45° field of view — 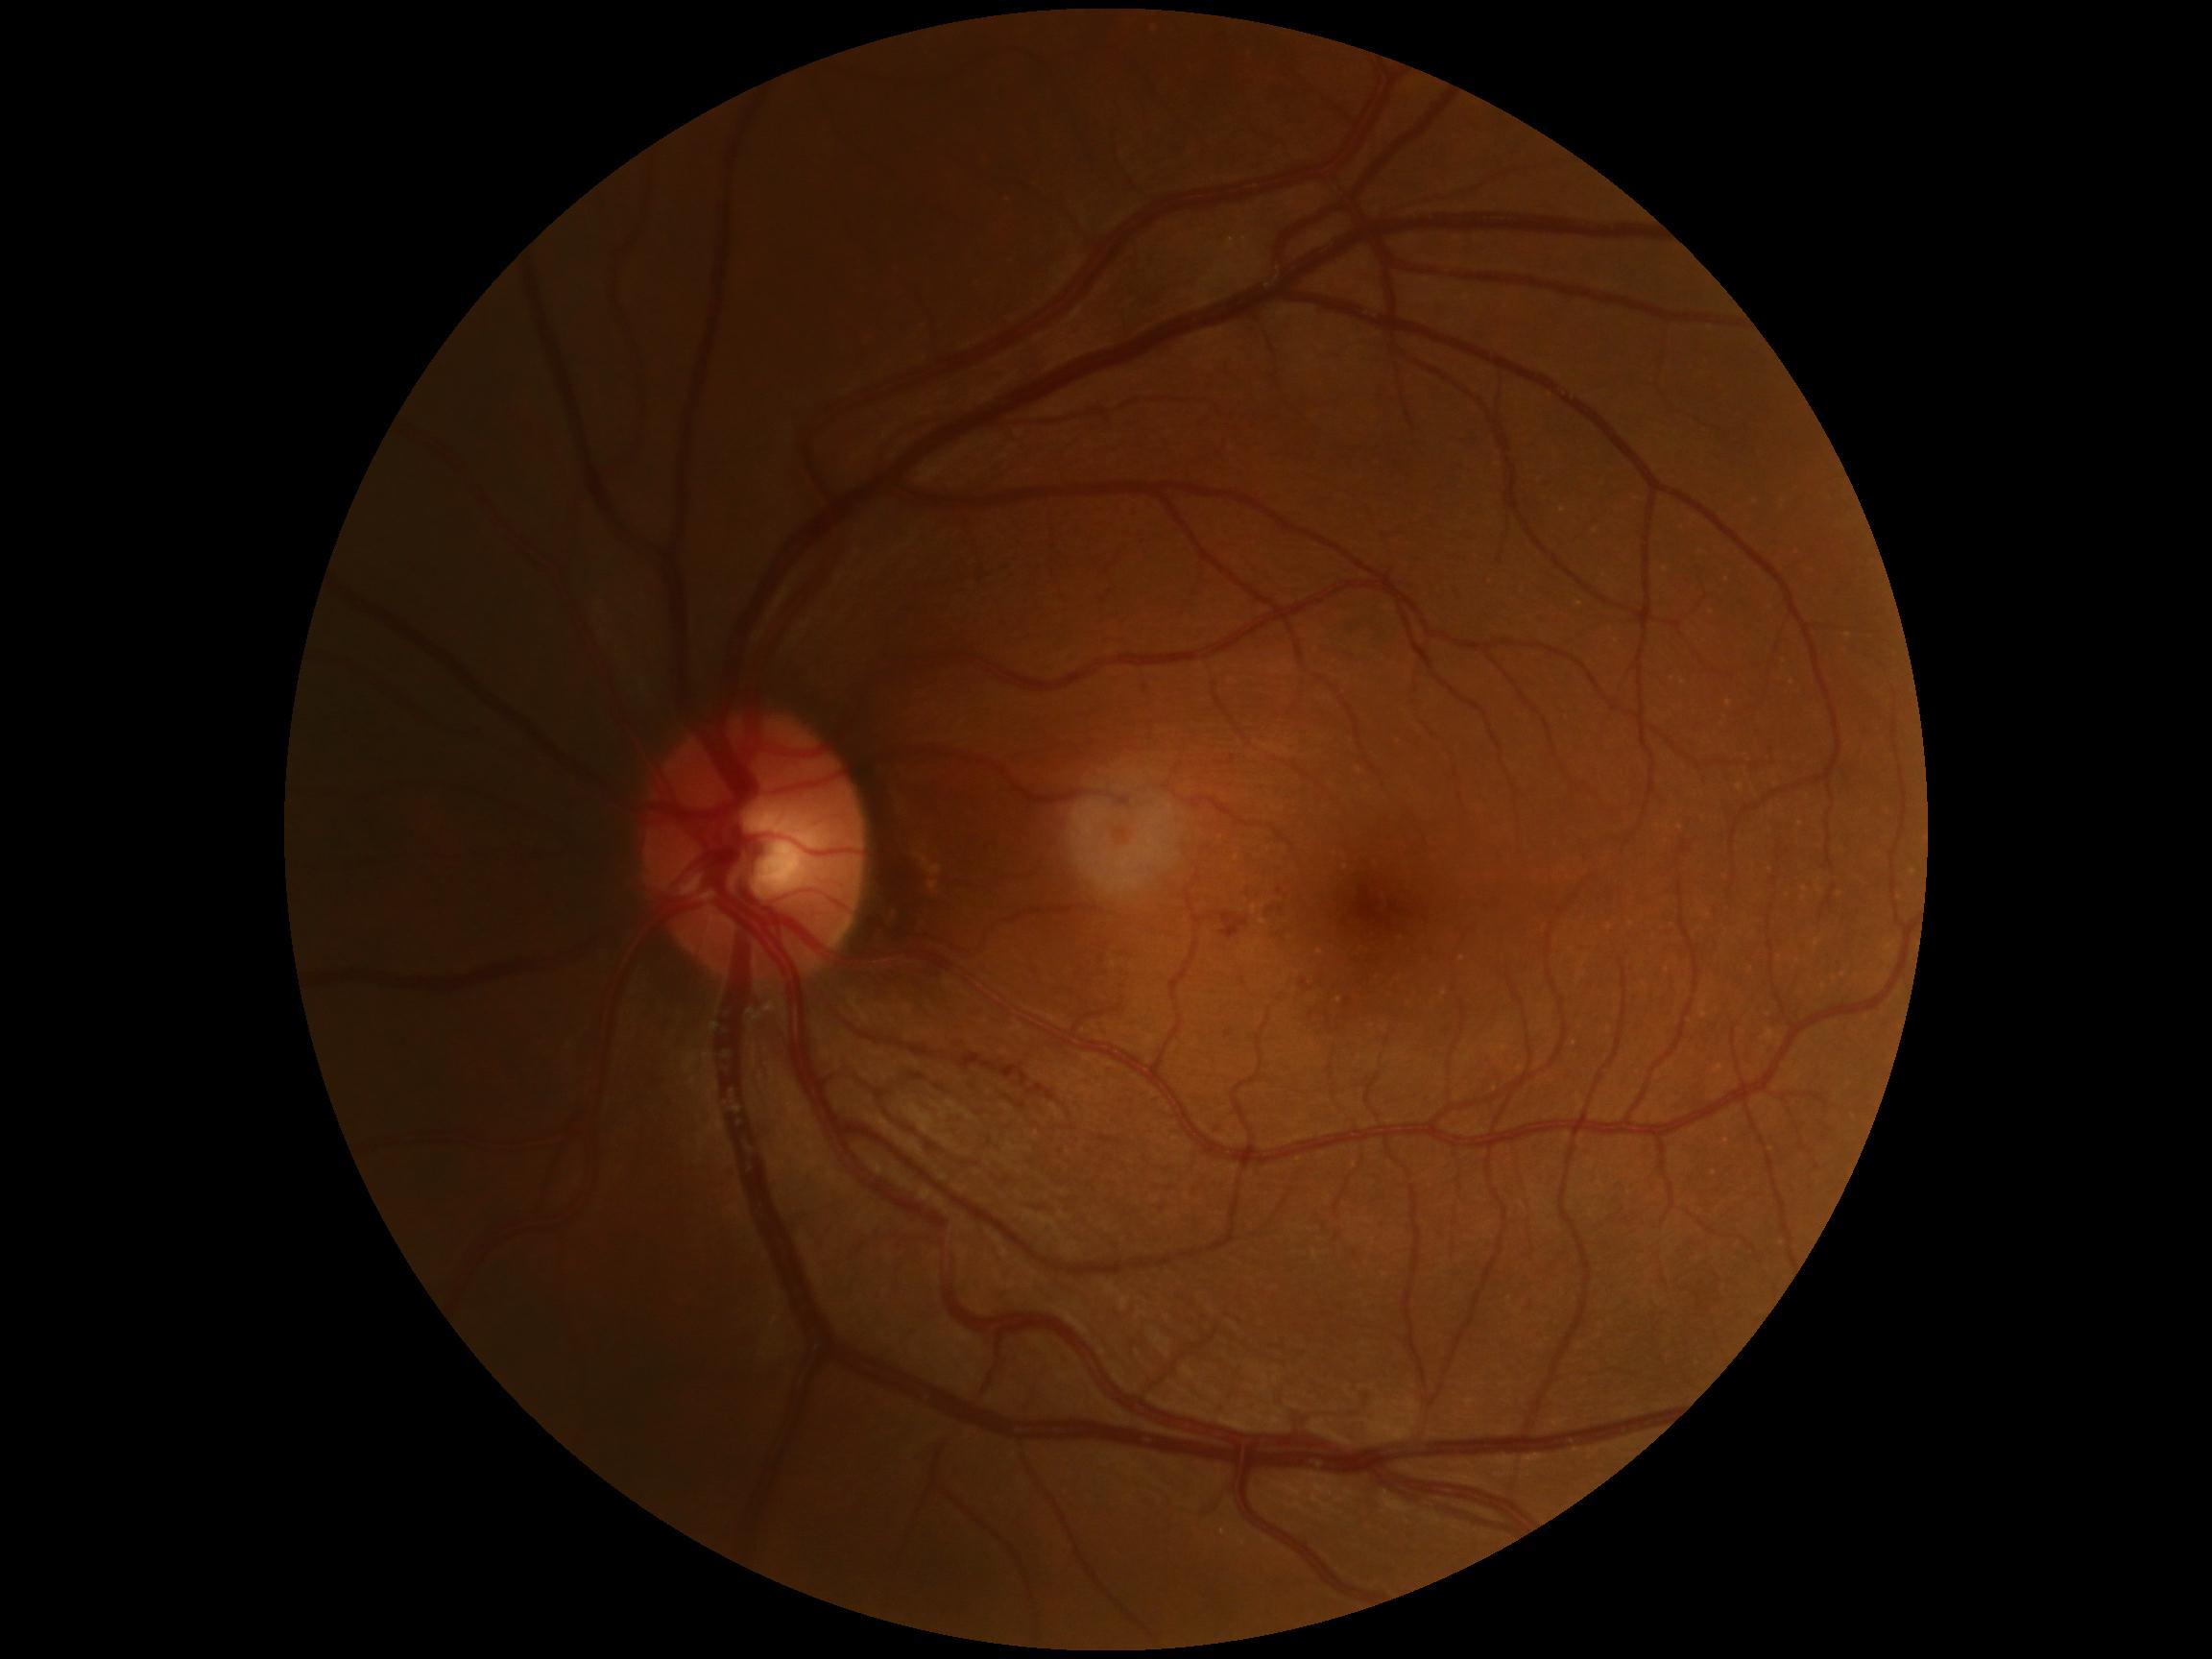 Findings:
* DR severity: grade 2 (moderate NPDR)